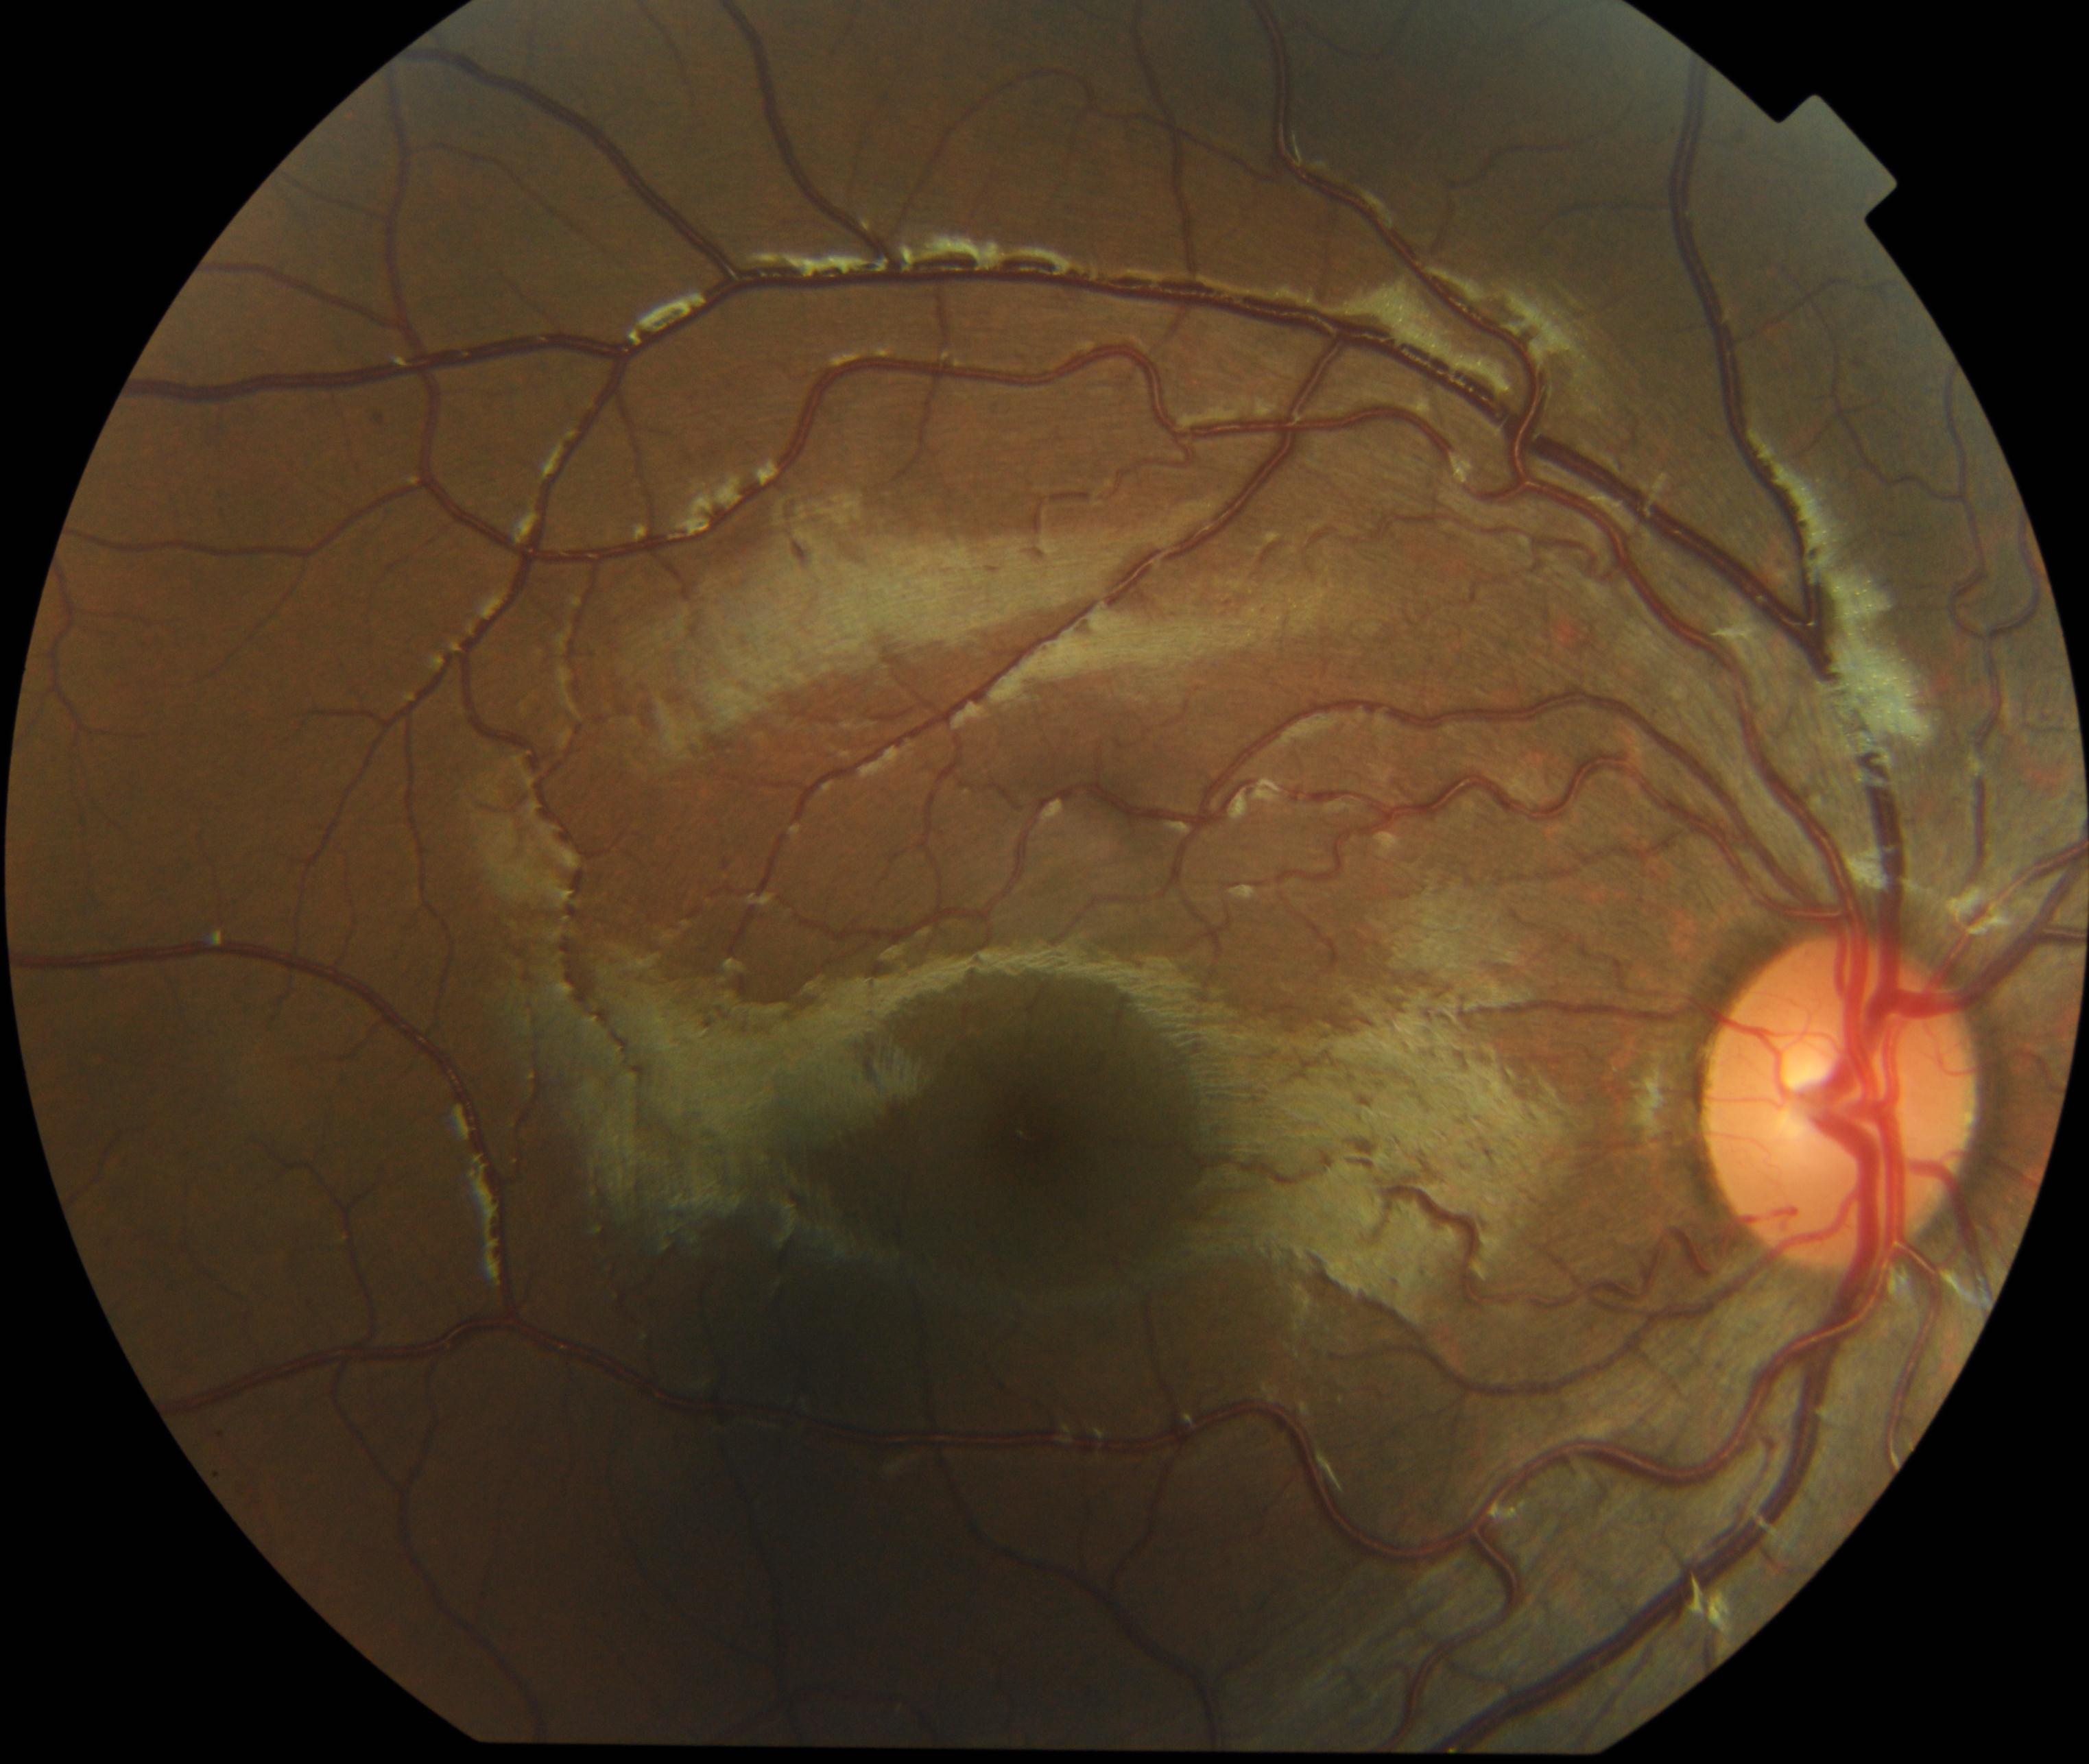 Demonstrates vessel tortuosity.